848 x 848 pixels: 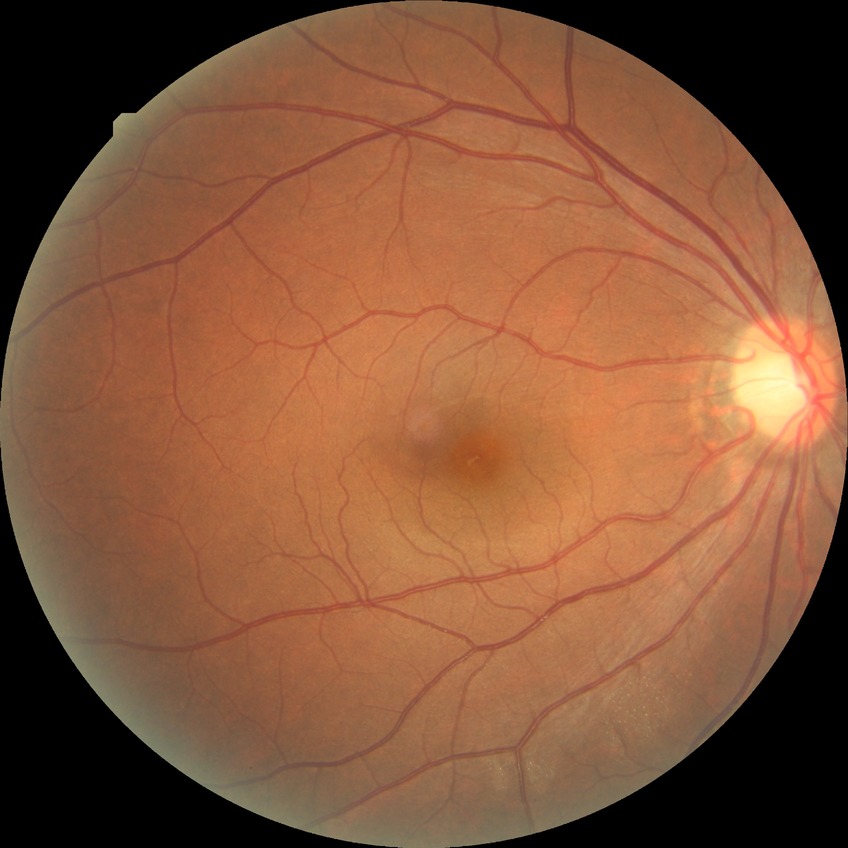 diabetic retinopathy stage = no diabetic retinopathy